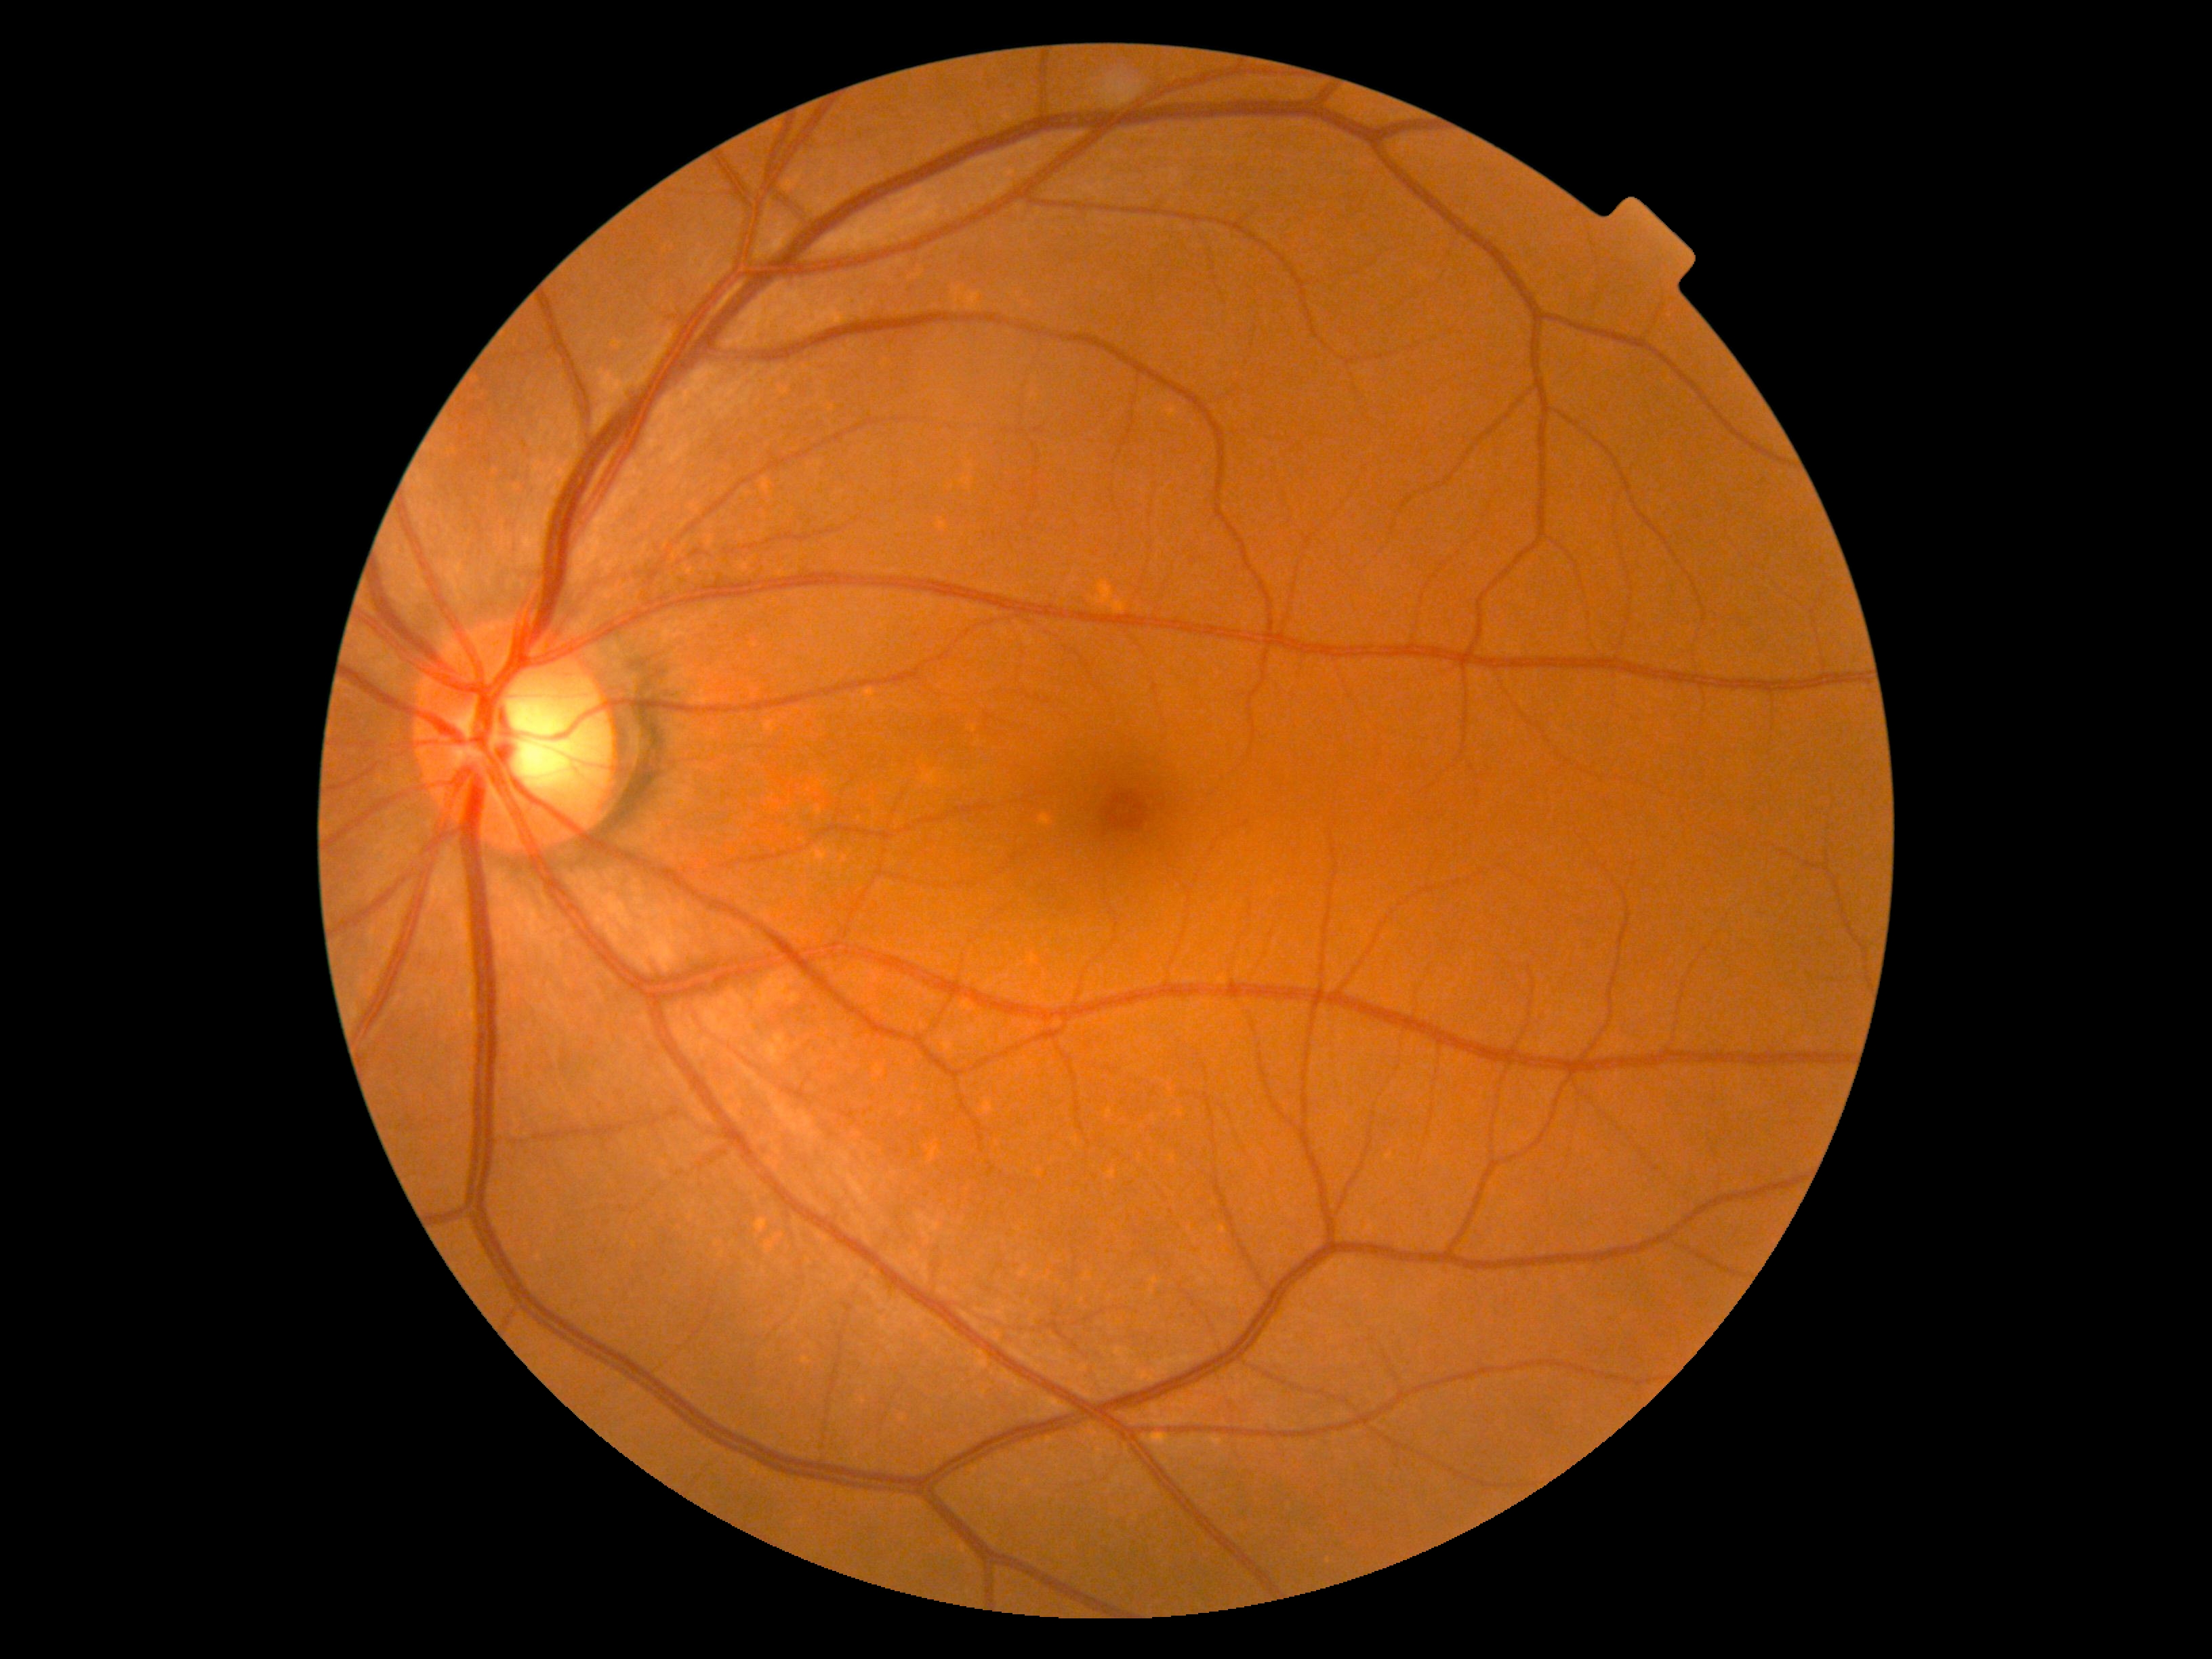 diabetic retinopathy = no apparent retinopathy (grade 0).